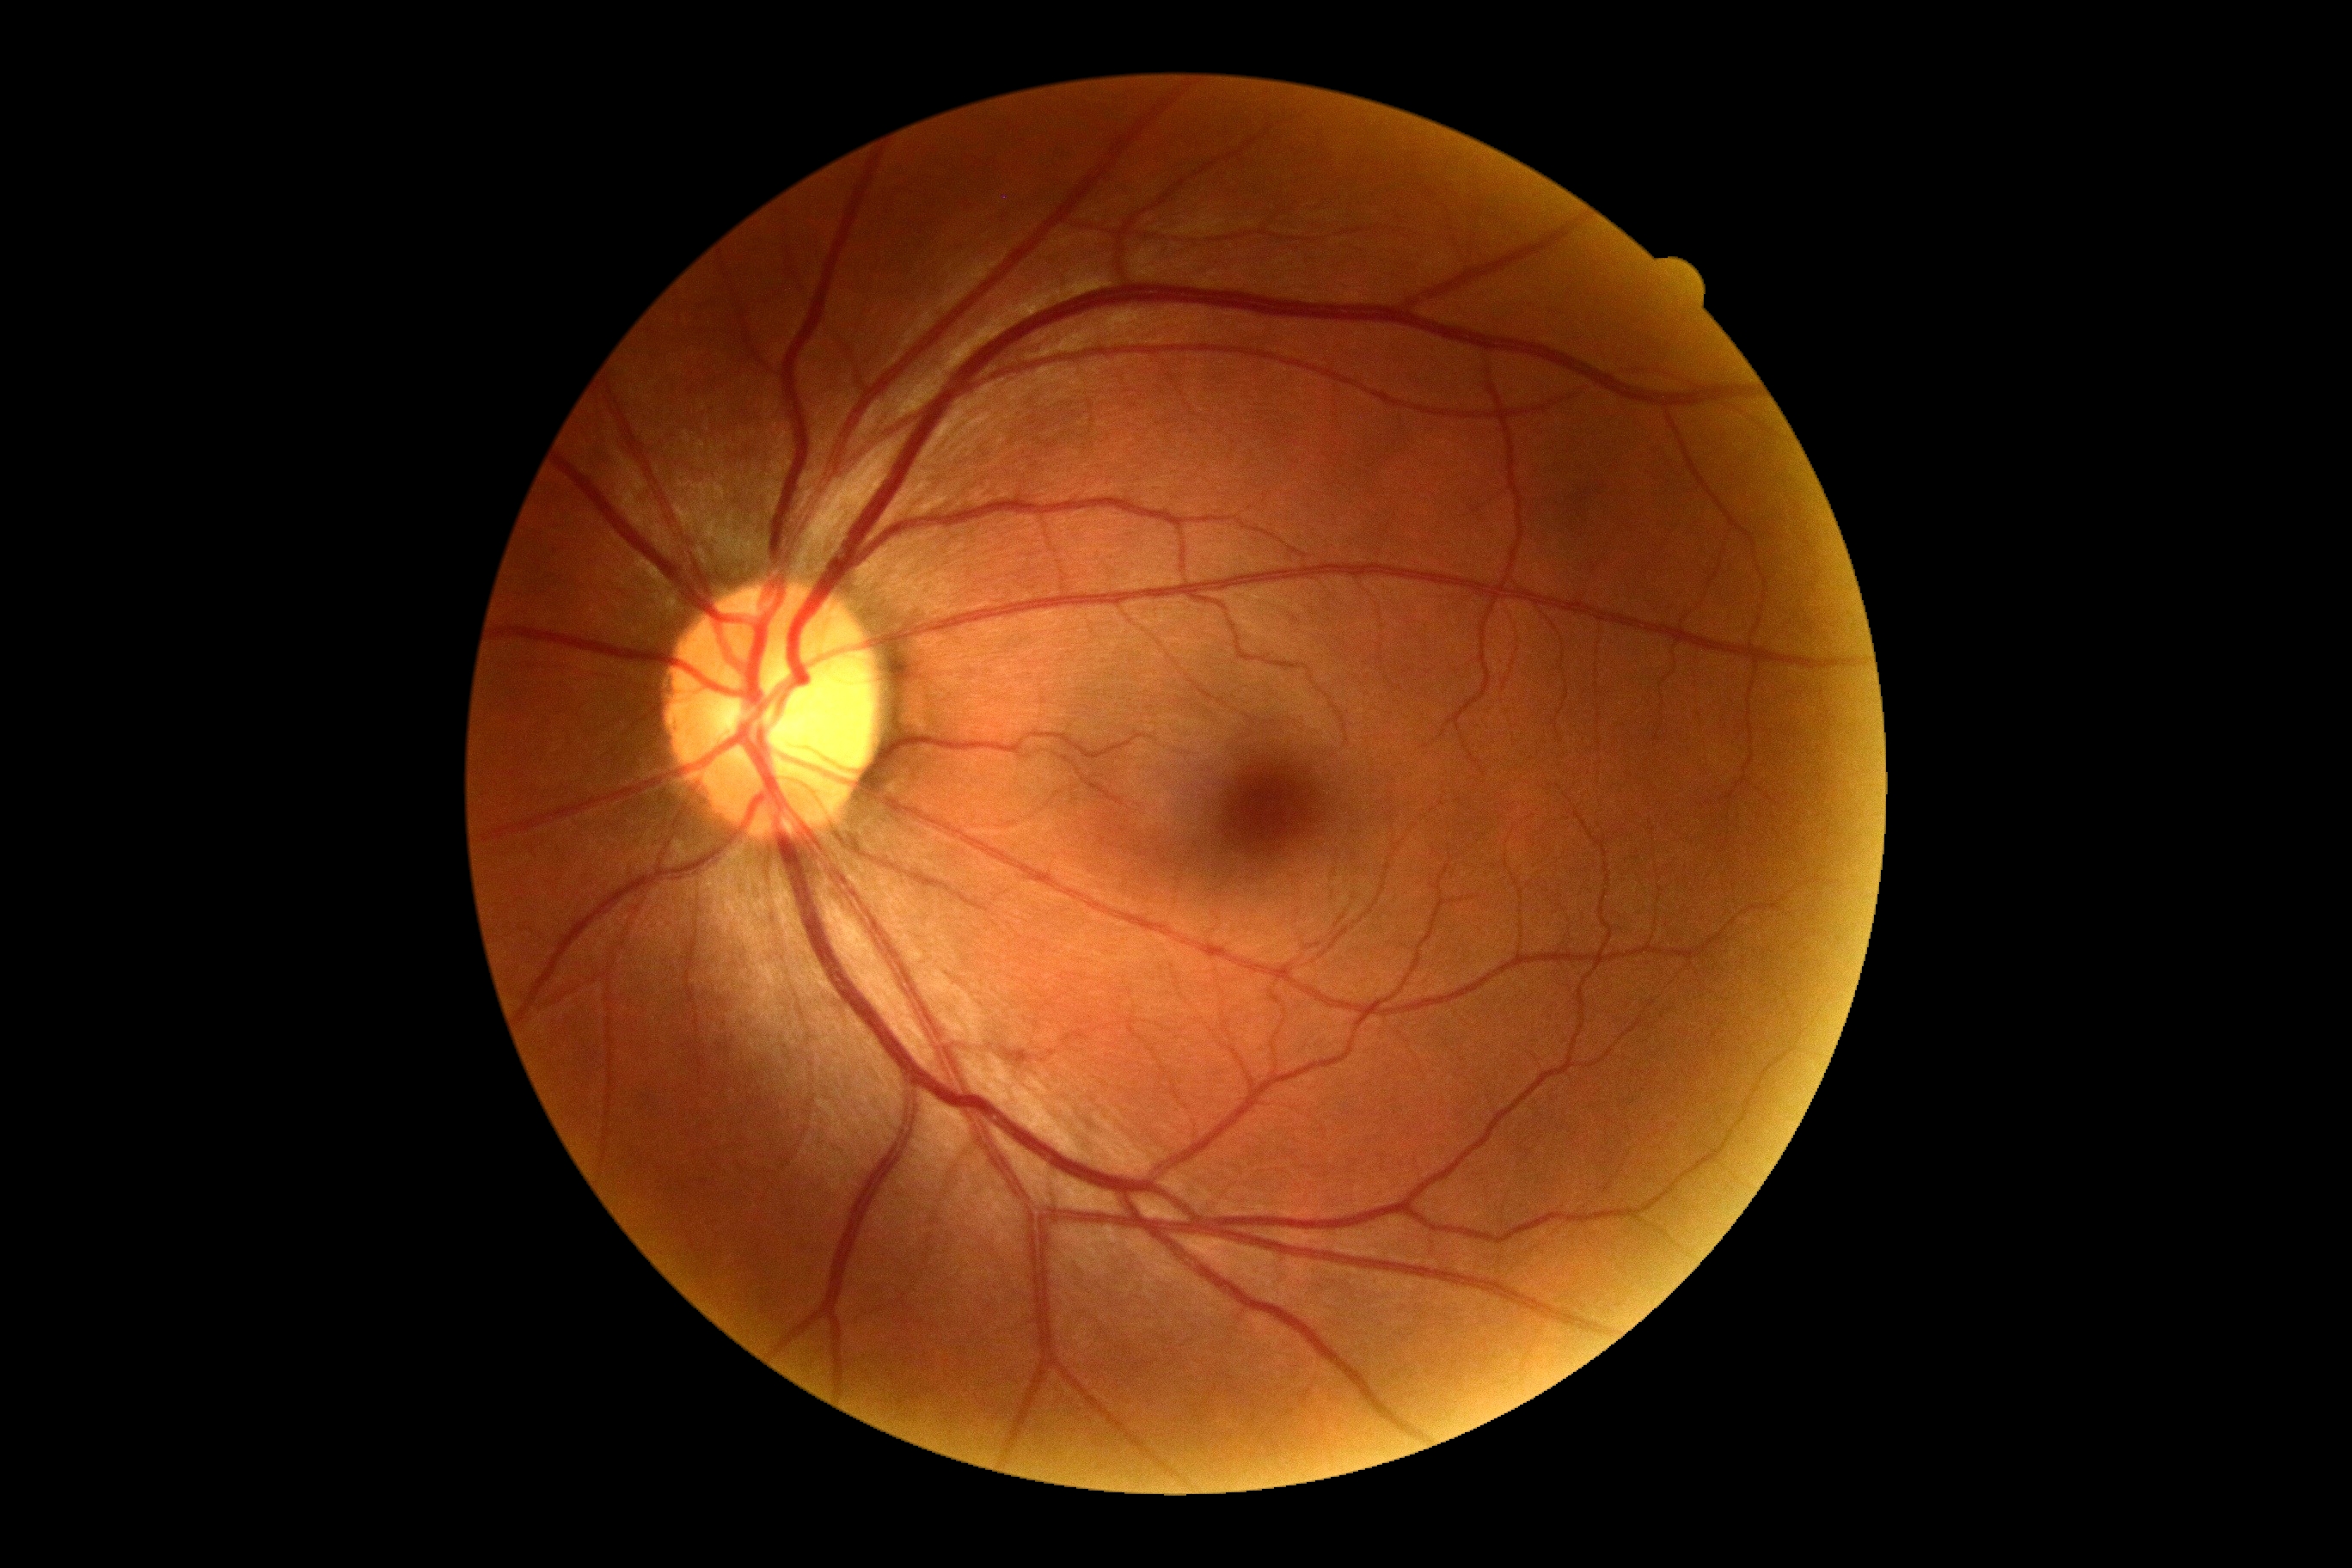
dr_grade: 0
dr_impression: no DR findings